FOV: 45 degrees, color fundus image.
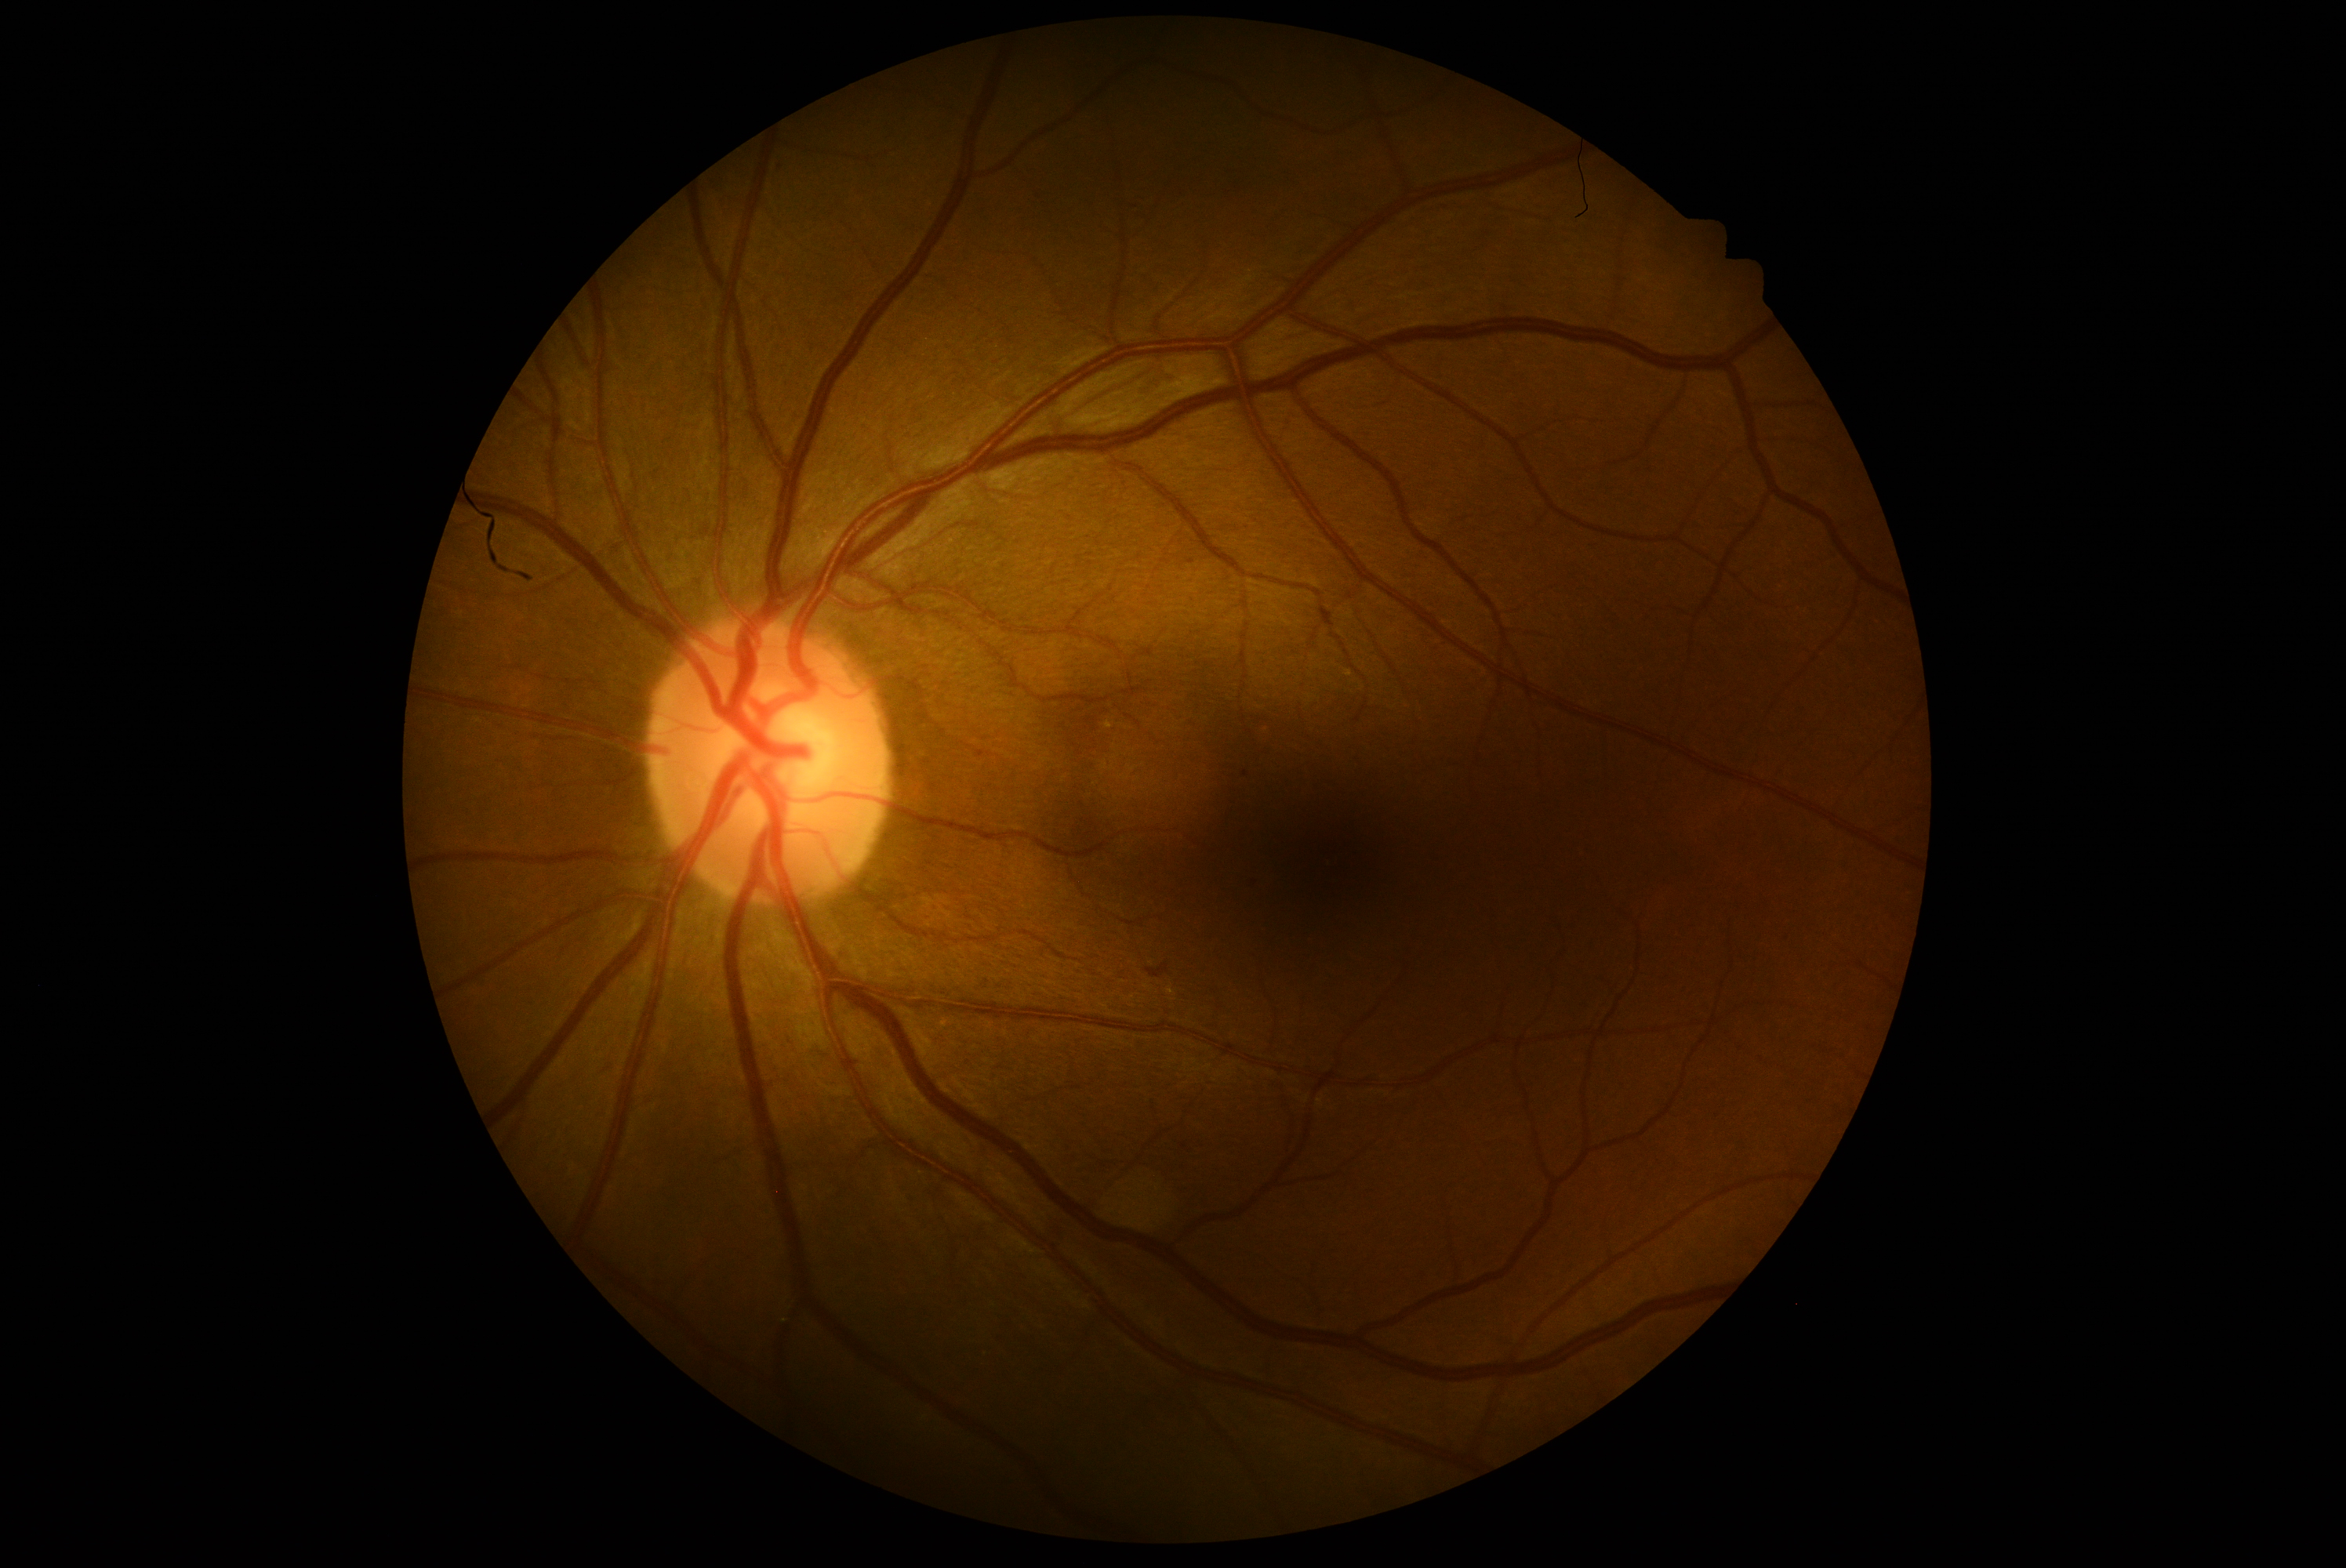

DR class: non-proliferative diabetic retinopathy; diabetic retinopathy (DR): grade 2 — more than just microaneurysms but less than severe NPDR.